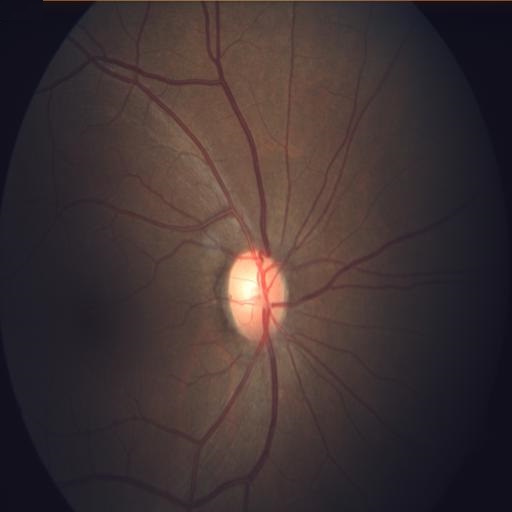
Fundus image with findings of tilted disc.